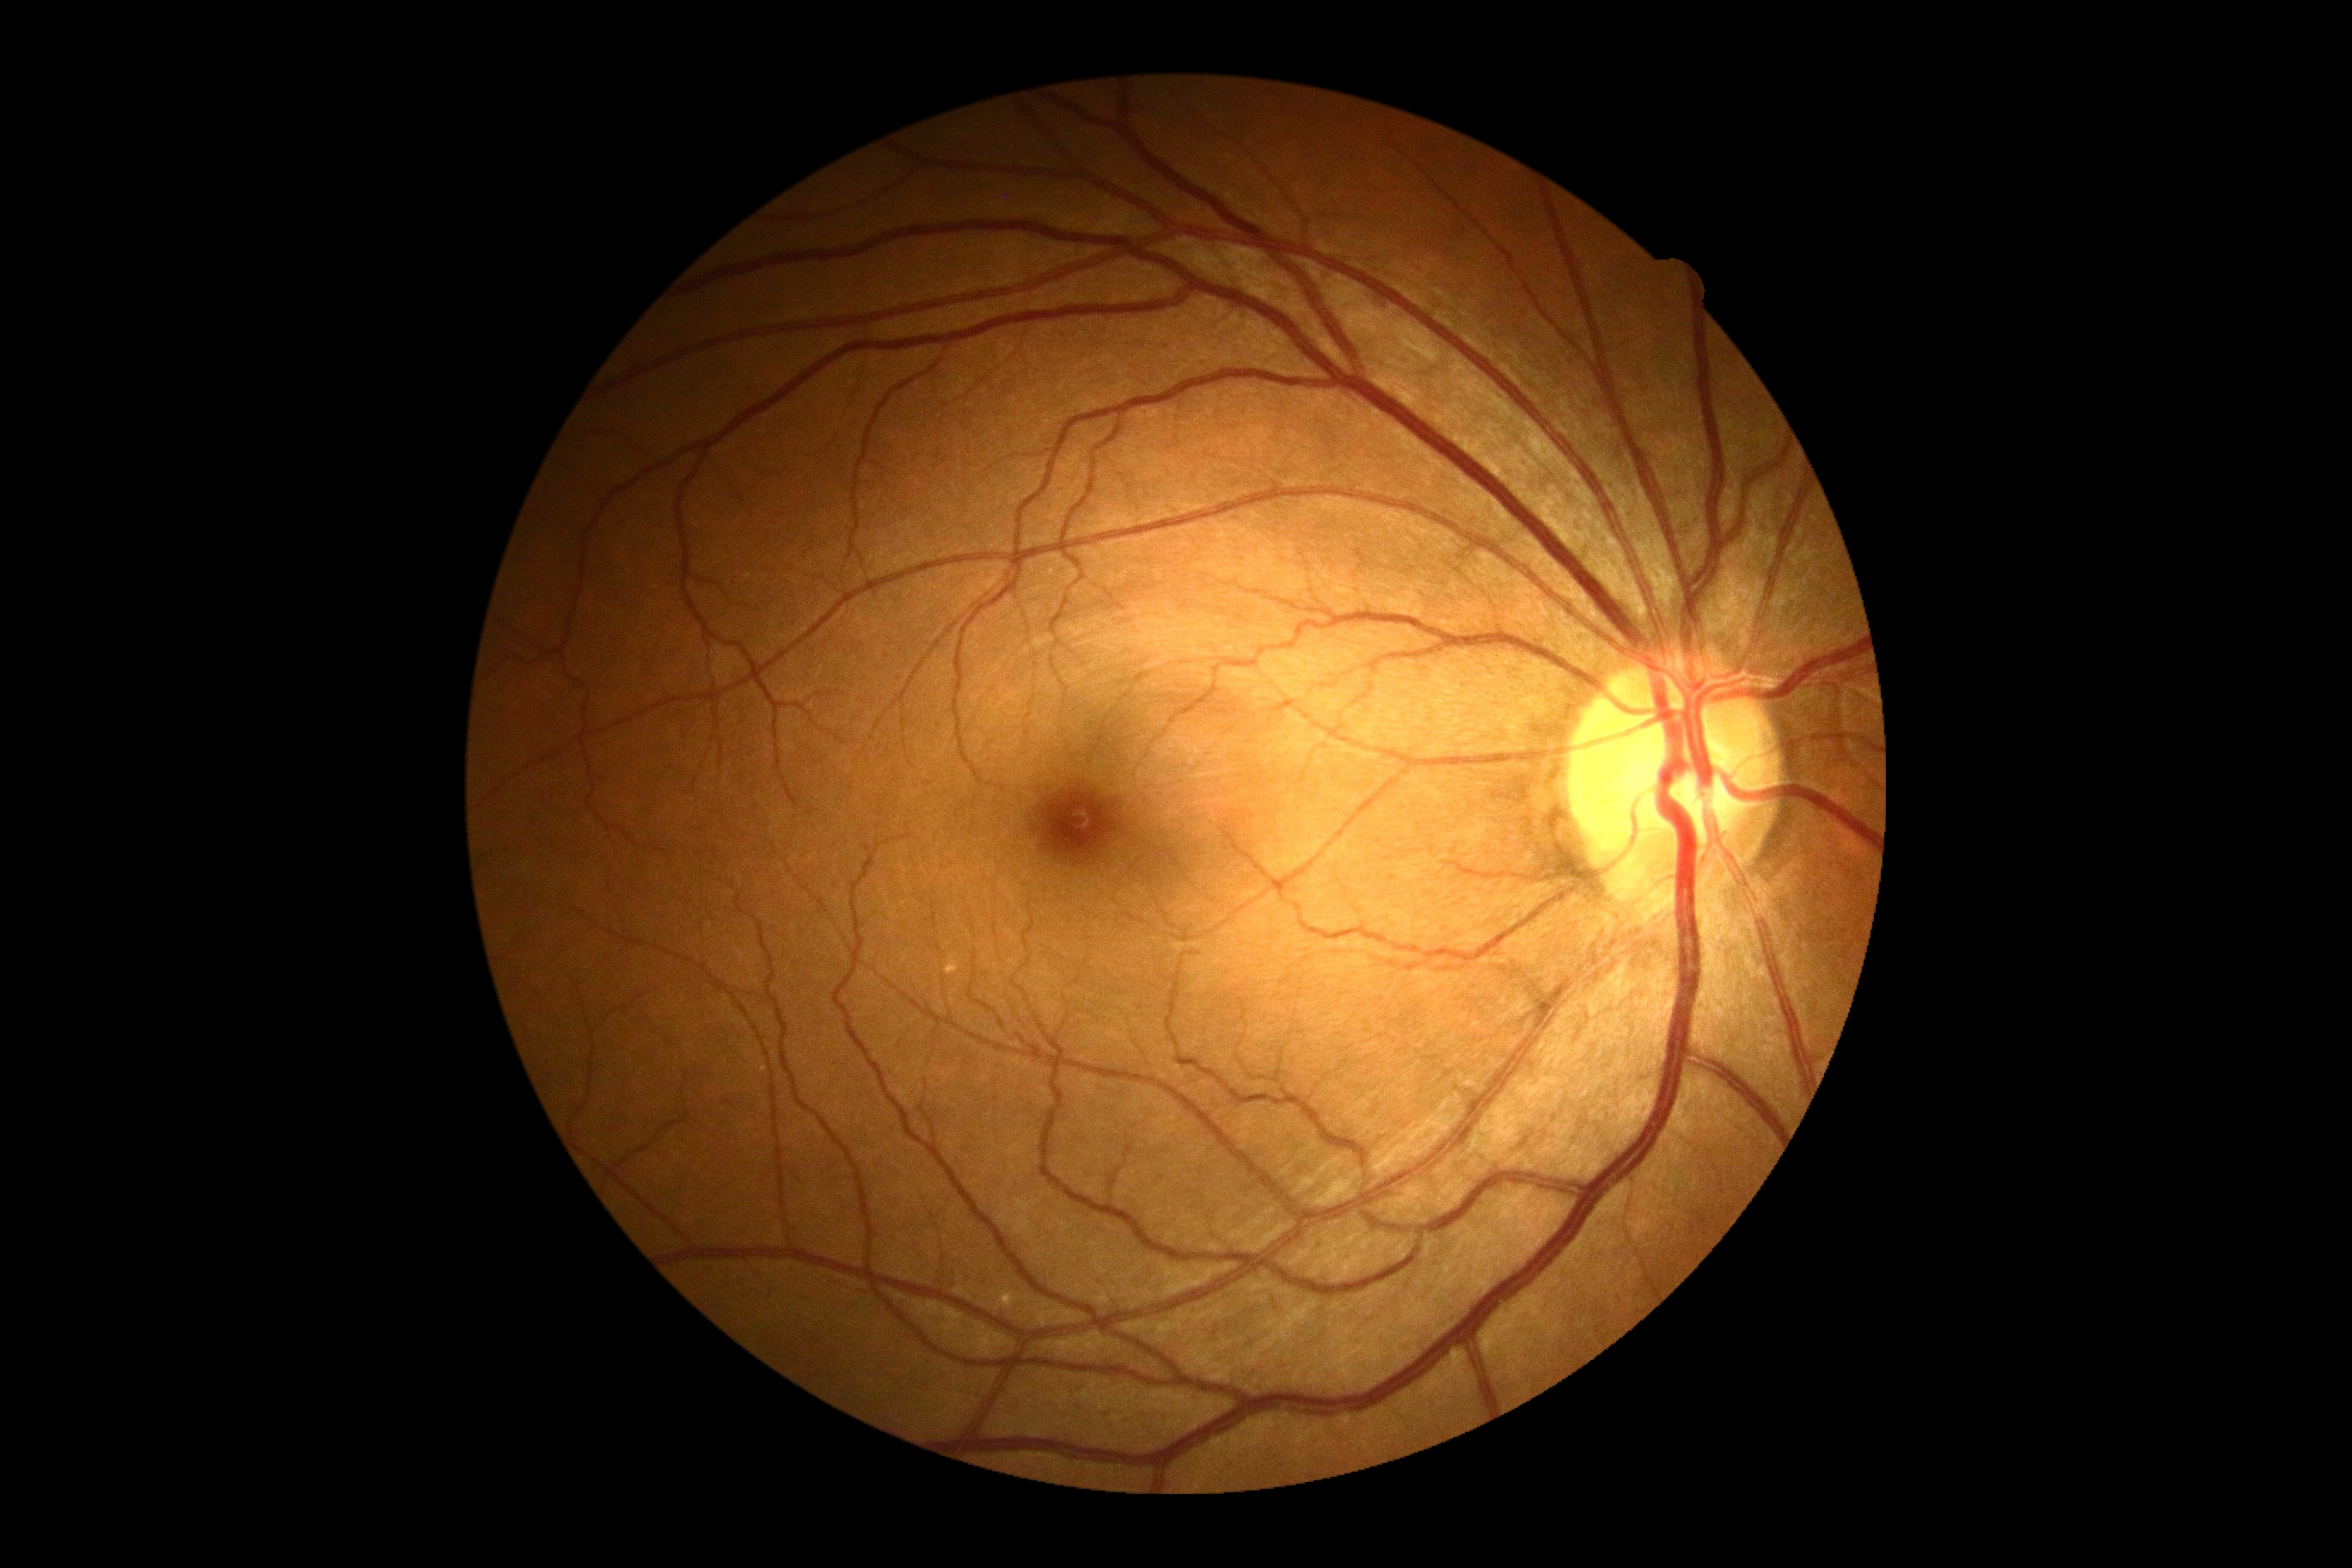

No signs of diabetic retinopathy.
Diabetic retinopathy (DR) is grade 0 (no apparent retinopathy).